45° FOV. No pharmacologic dilation: 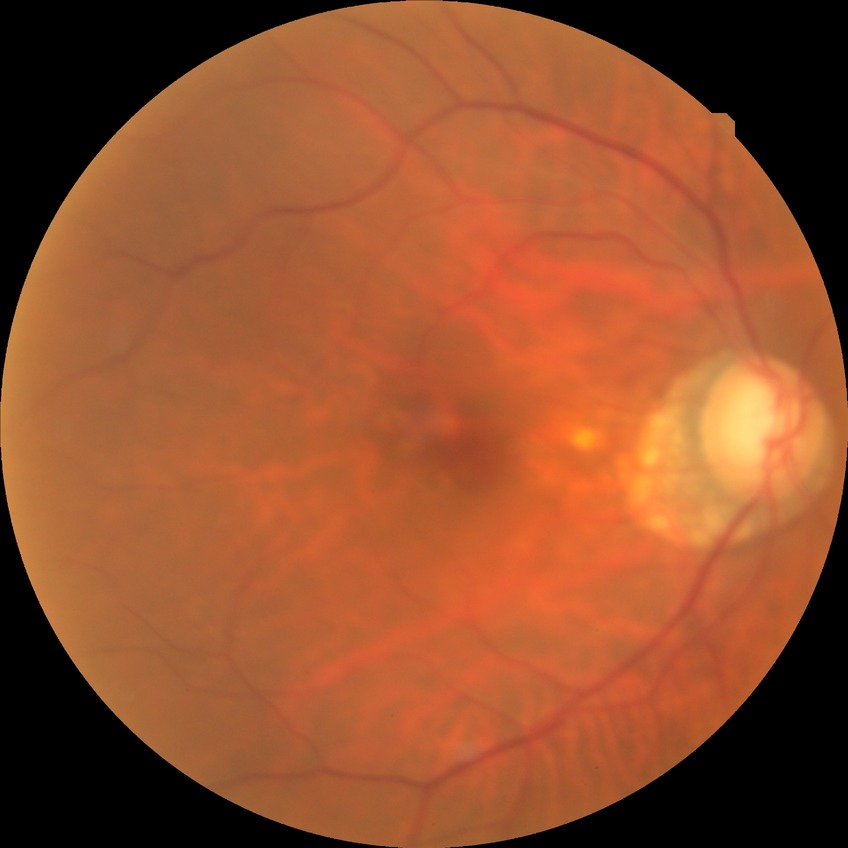
Diabetic retinopathy (DR) is no diabetic retinopathy (NDR).